Nonmydriatic — 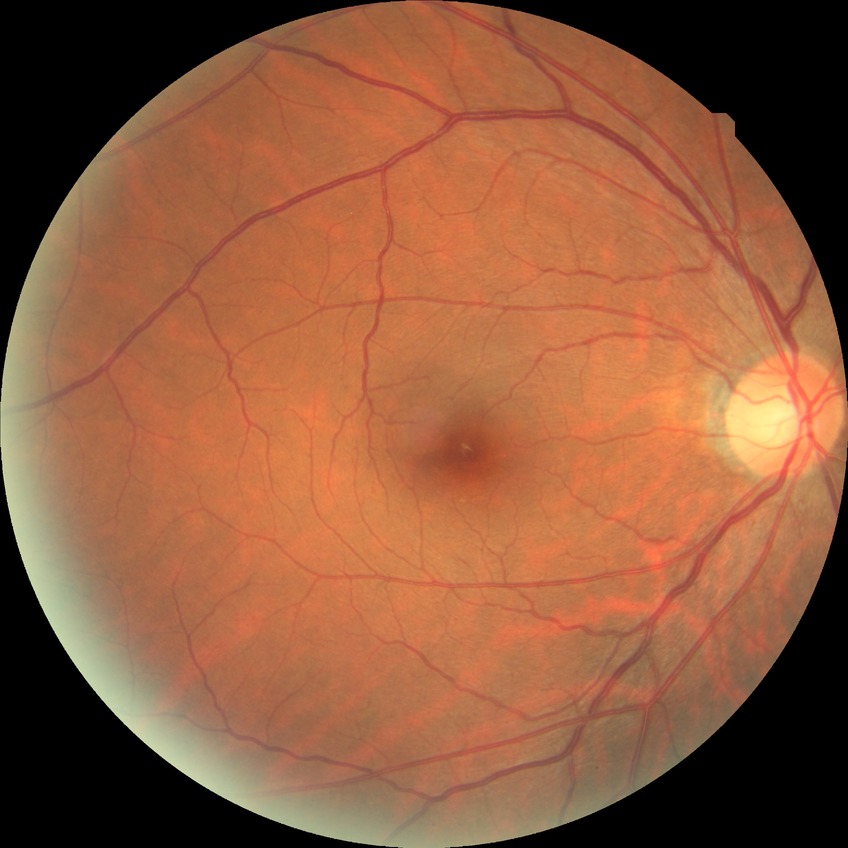 {"davis_grade": "no diabetic retinopathy"}